Infant wide-field retinal image. Phoenix ICON, 100° FOV.
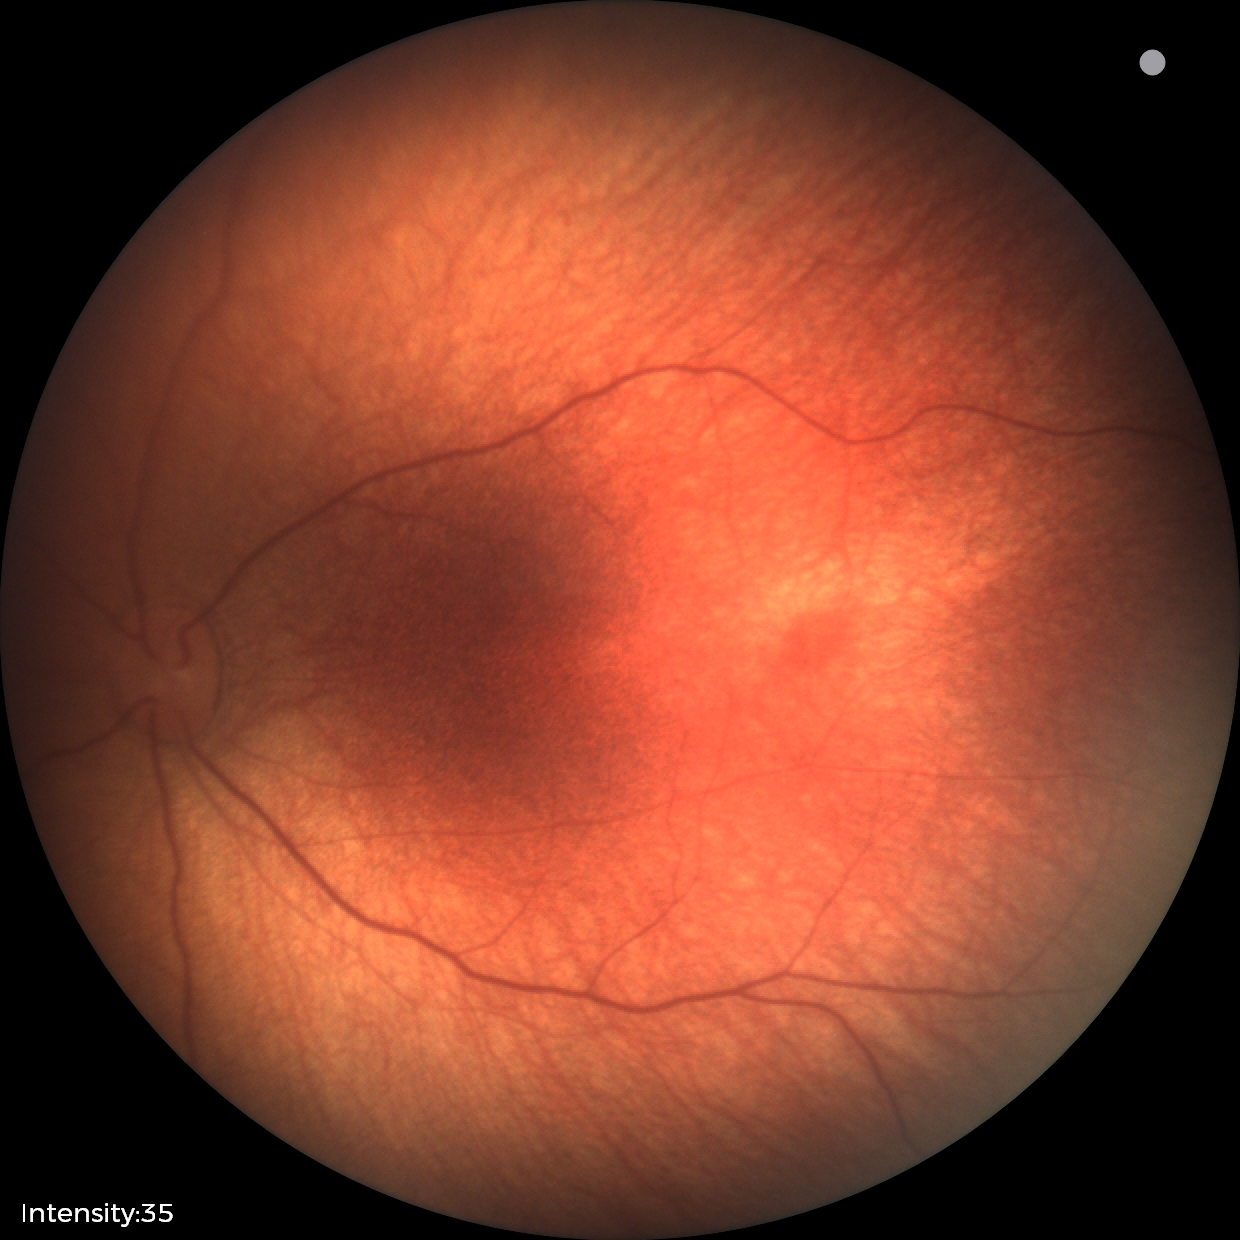

Physiological retinal appearance for postconceptual age.